Retinal fundus photograph.
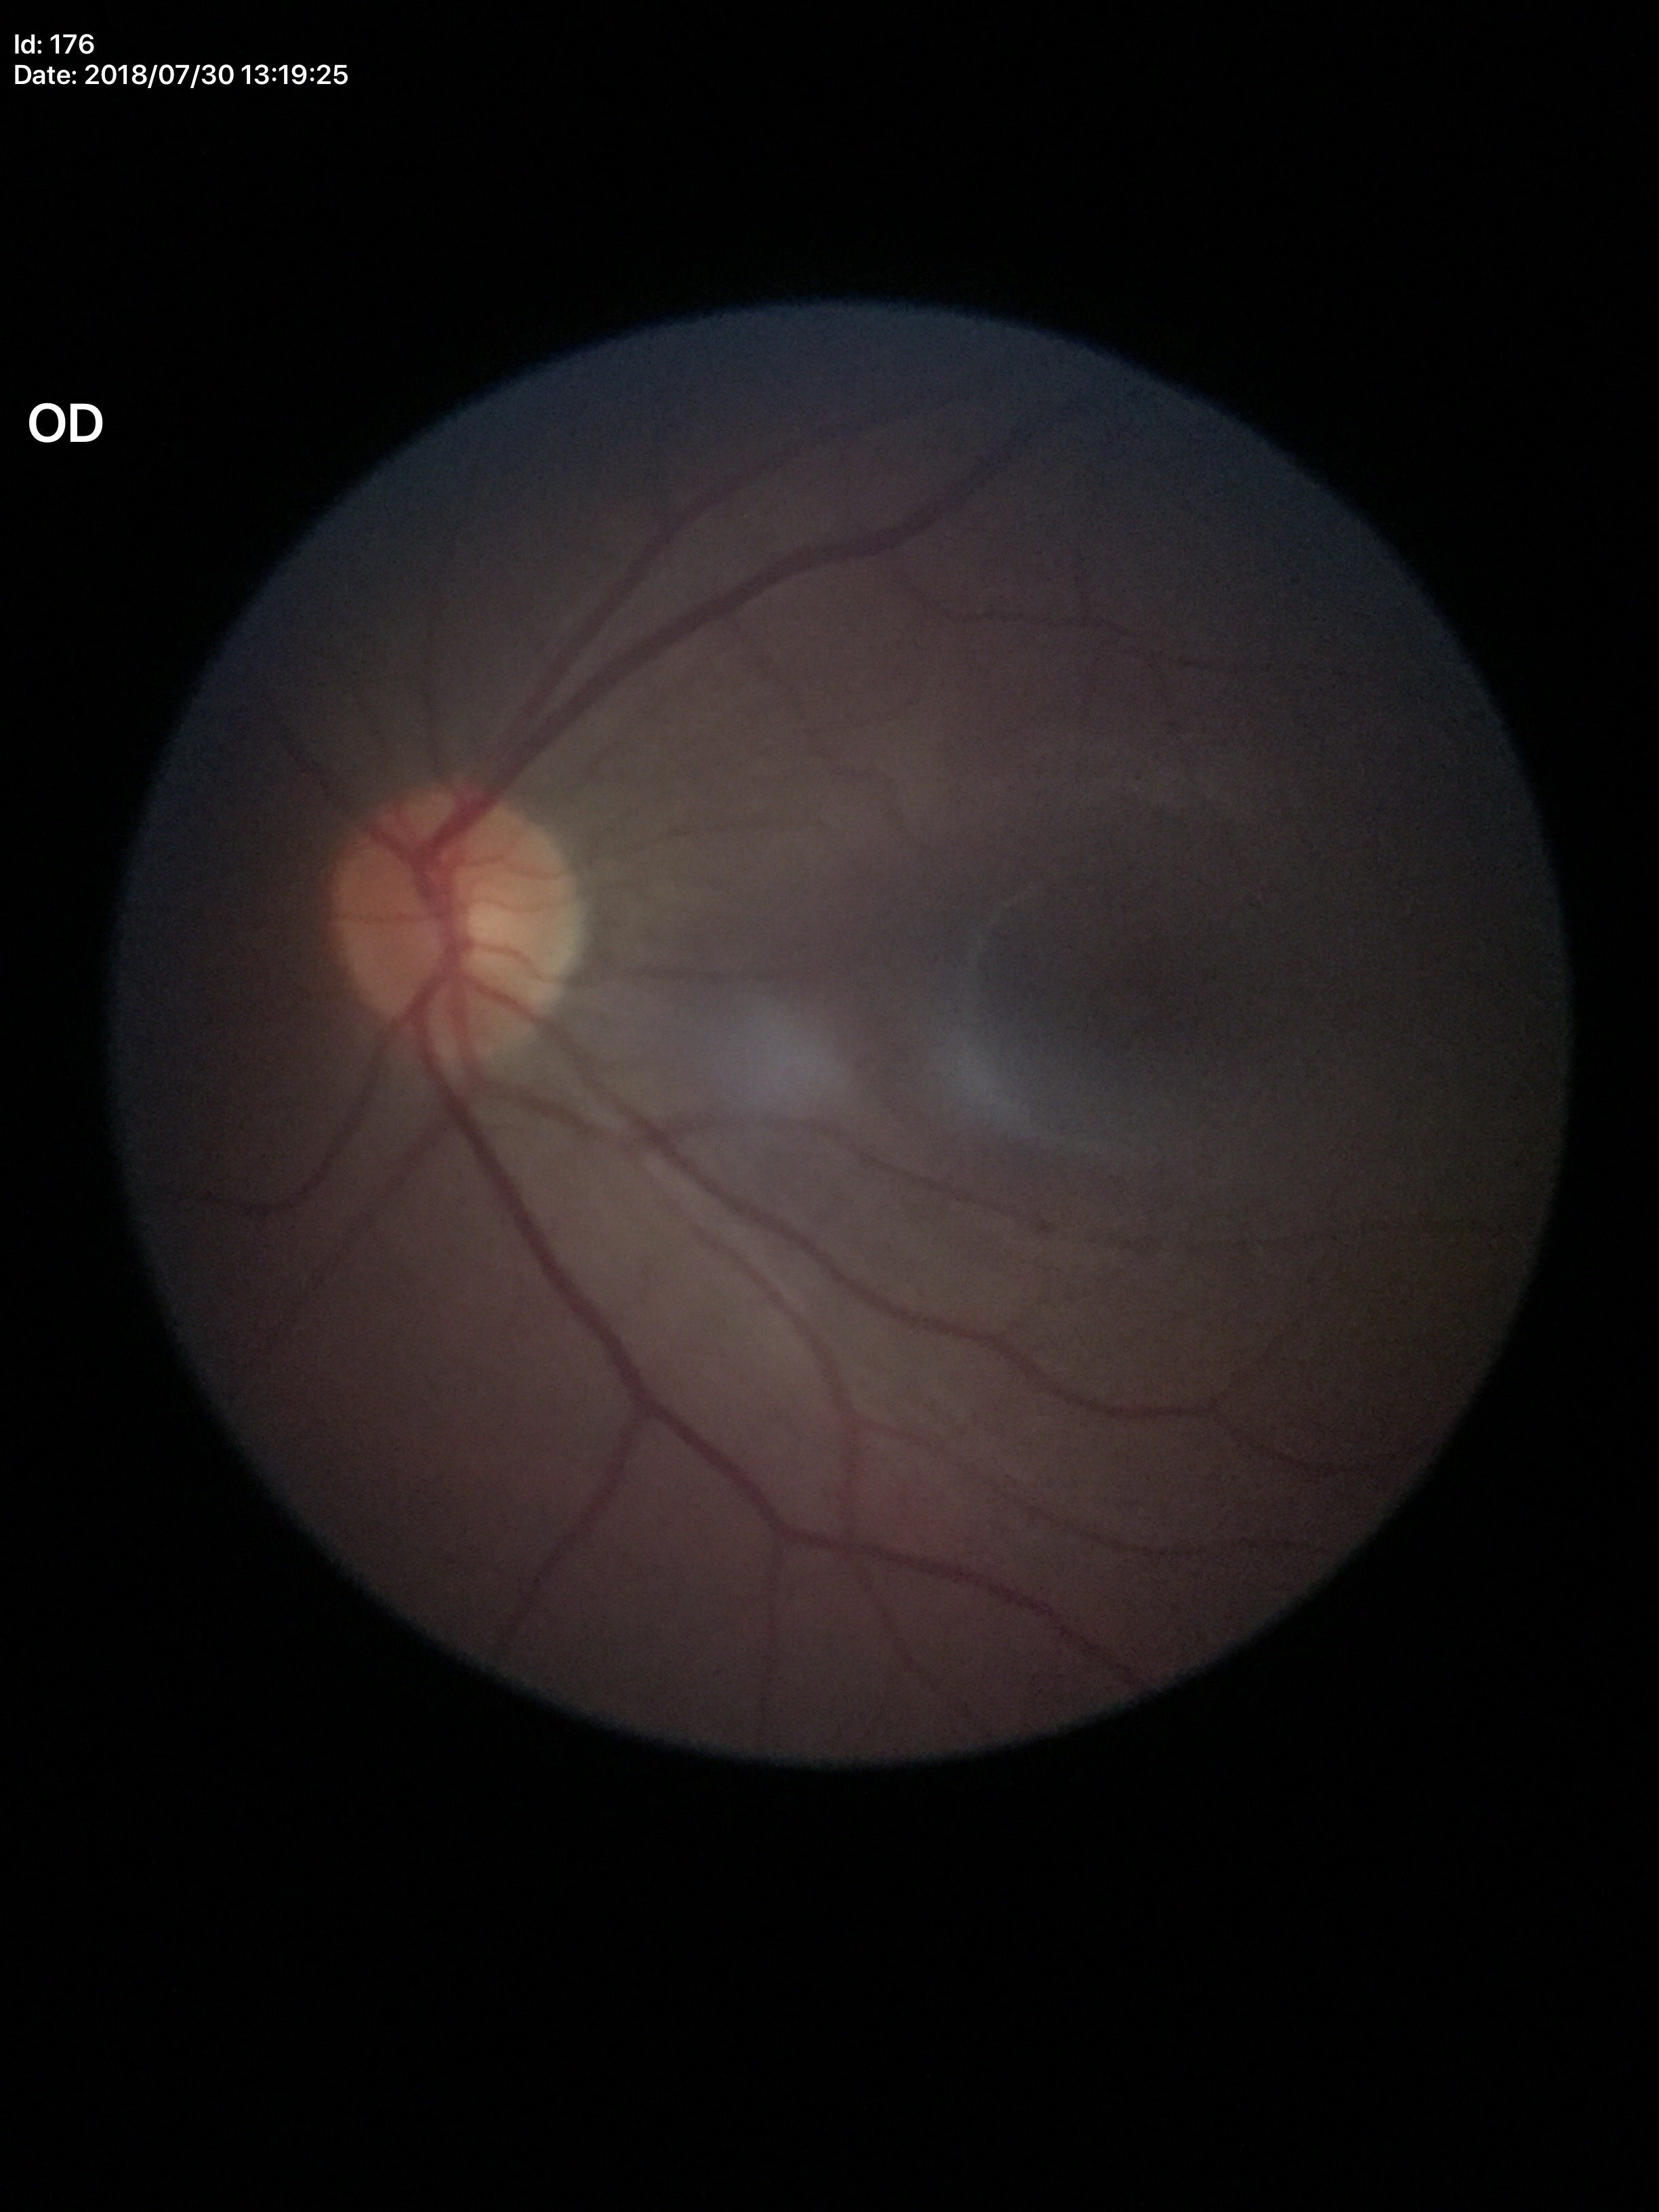
No signs of glaucoma. VCDR is 0.45. HCDR of 0.45. ACDR of 0.20.